50° FOV · camera: Topcon TRC-NW8 — 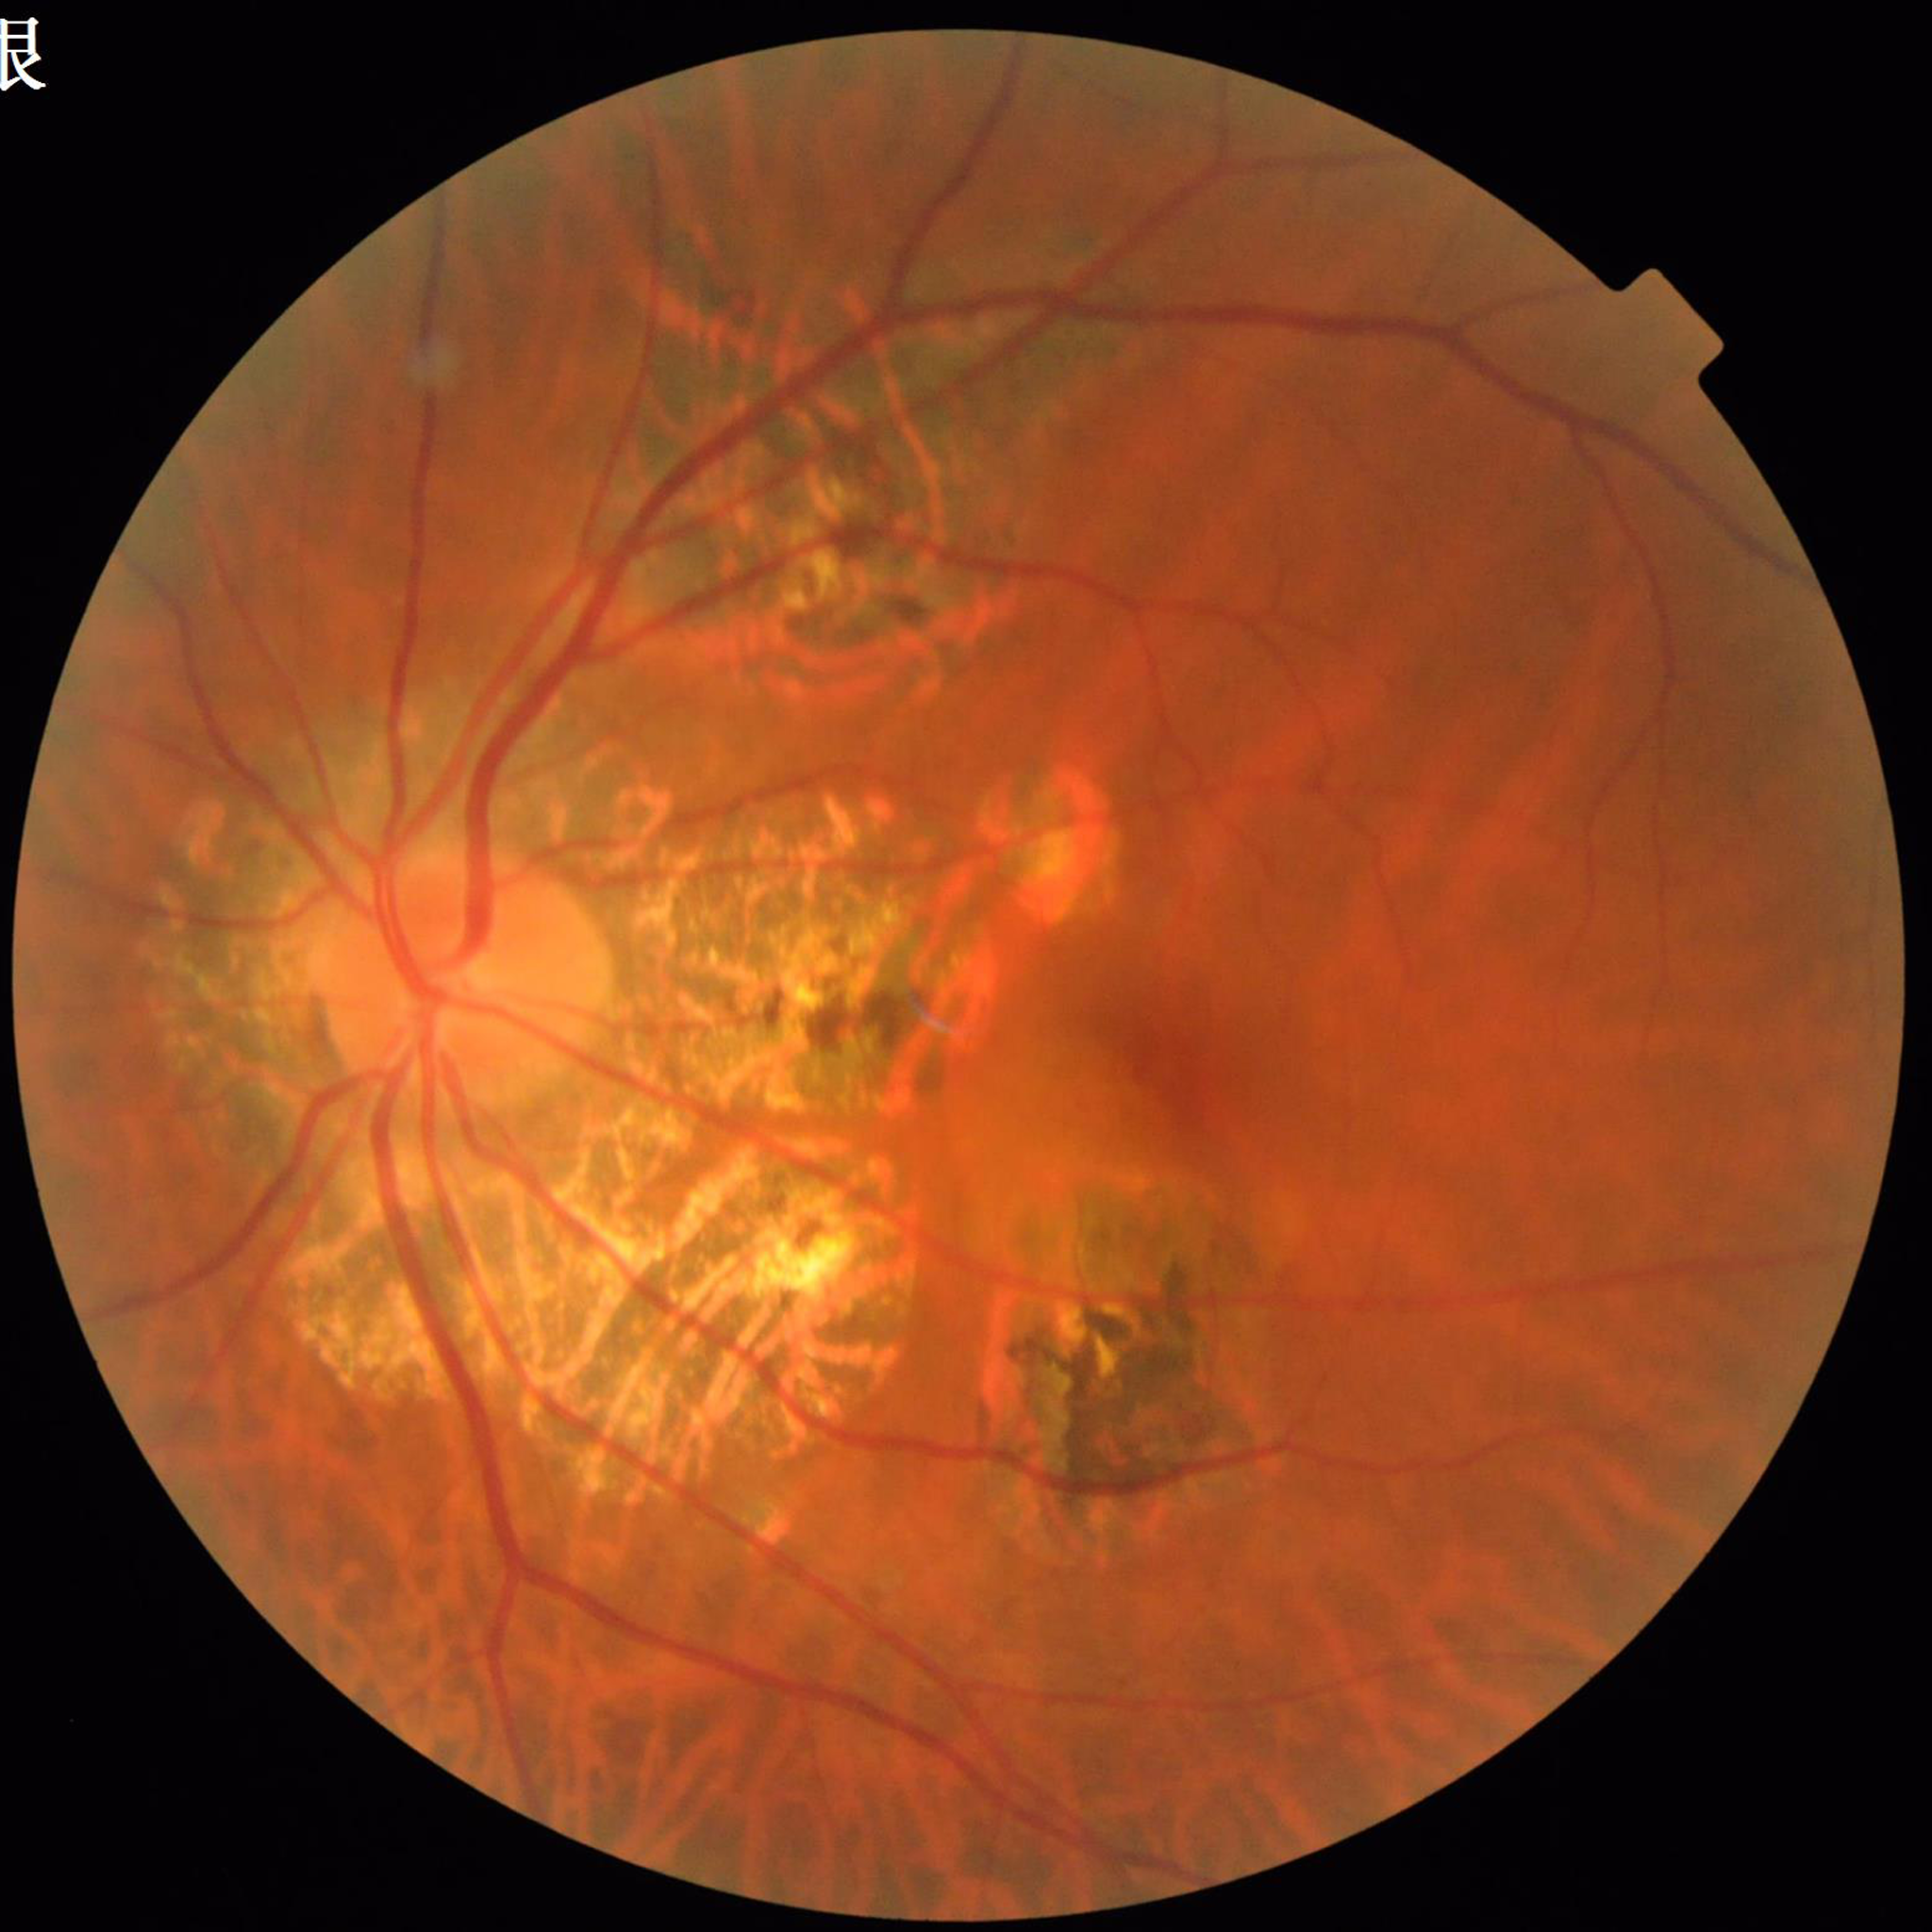

  diagnosis: age-related macular degeneration (AMD)